Camera: Topcon TRC-50DX; dilated-pupil acquisition; FOV: 50 degrees; 2228x1652; color fundus image — 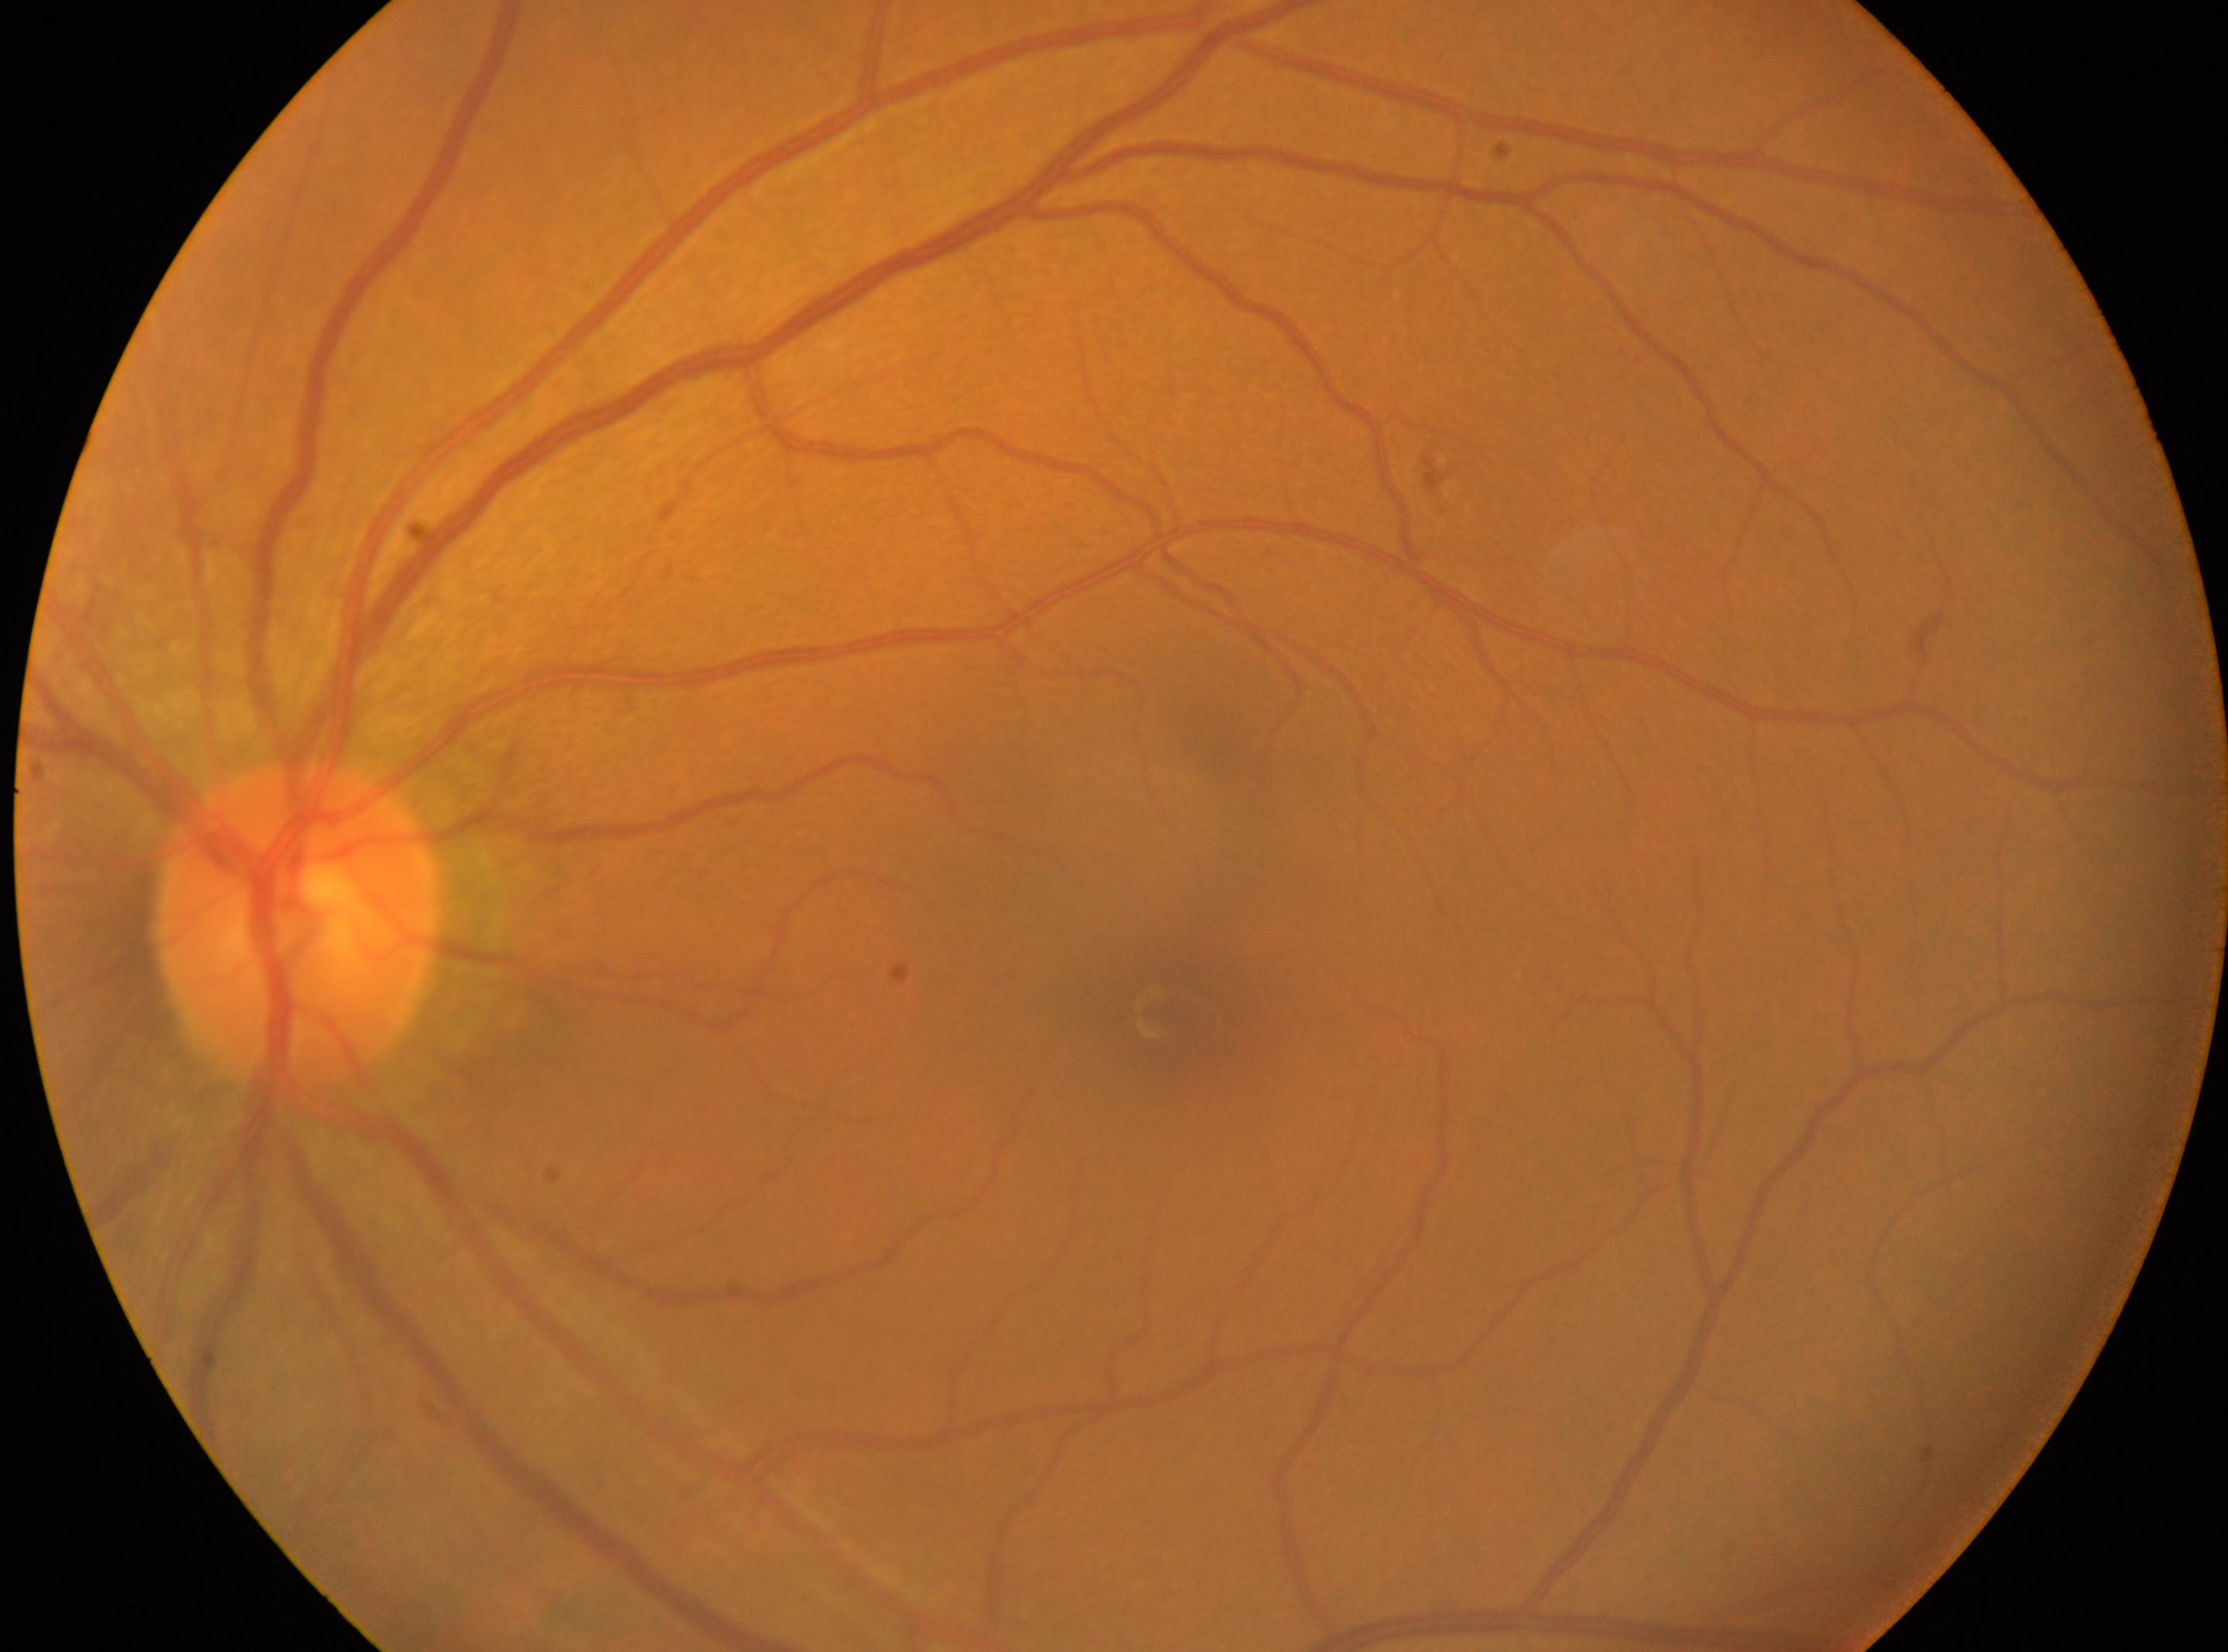
This is the oculus sinister. Disc center: x=299, y=926. The foveal center is at x=1164, y=1012. Retinopathy is no apparent retinopathy (grade 0). No apparent diabetic retinopathy.